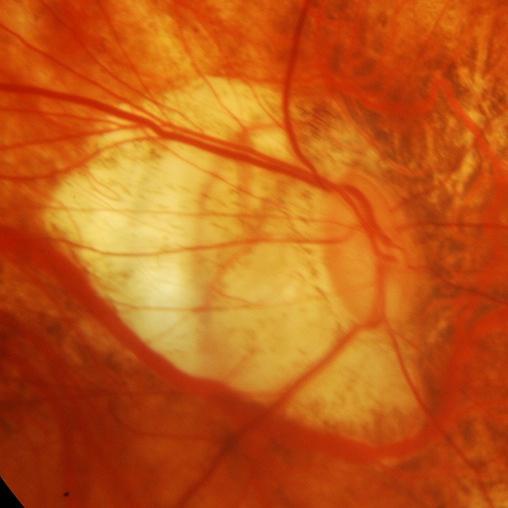

Glaucomatous optic neuropathy is present. Optic nerve head appearance consistent with glaucomatous damage to the optic nerve.